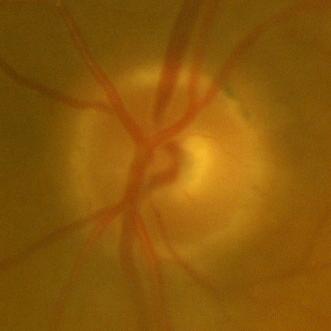

Consistent with no glaucoma.